Infant wide-field fundus photograph · 1240 by 1240 pixels
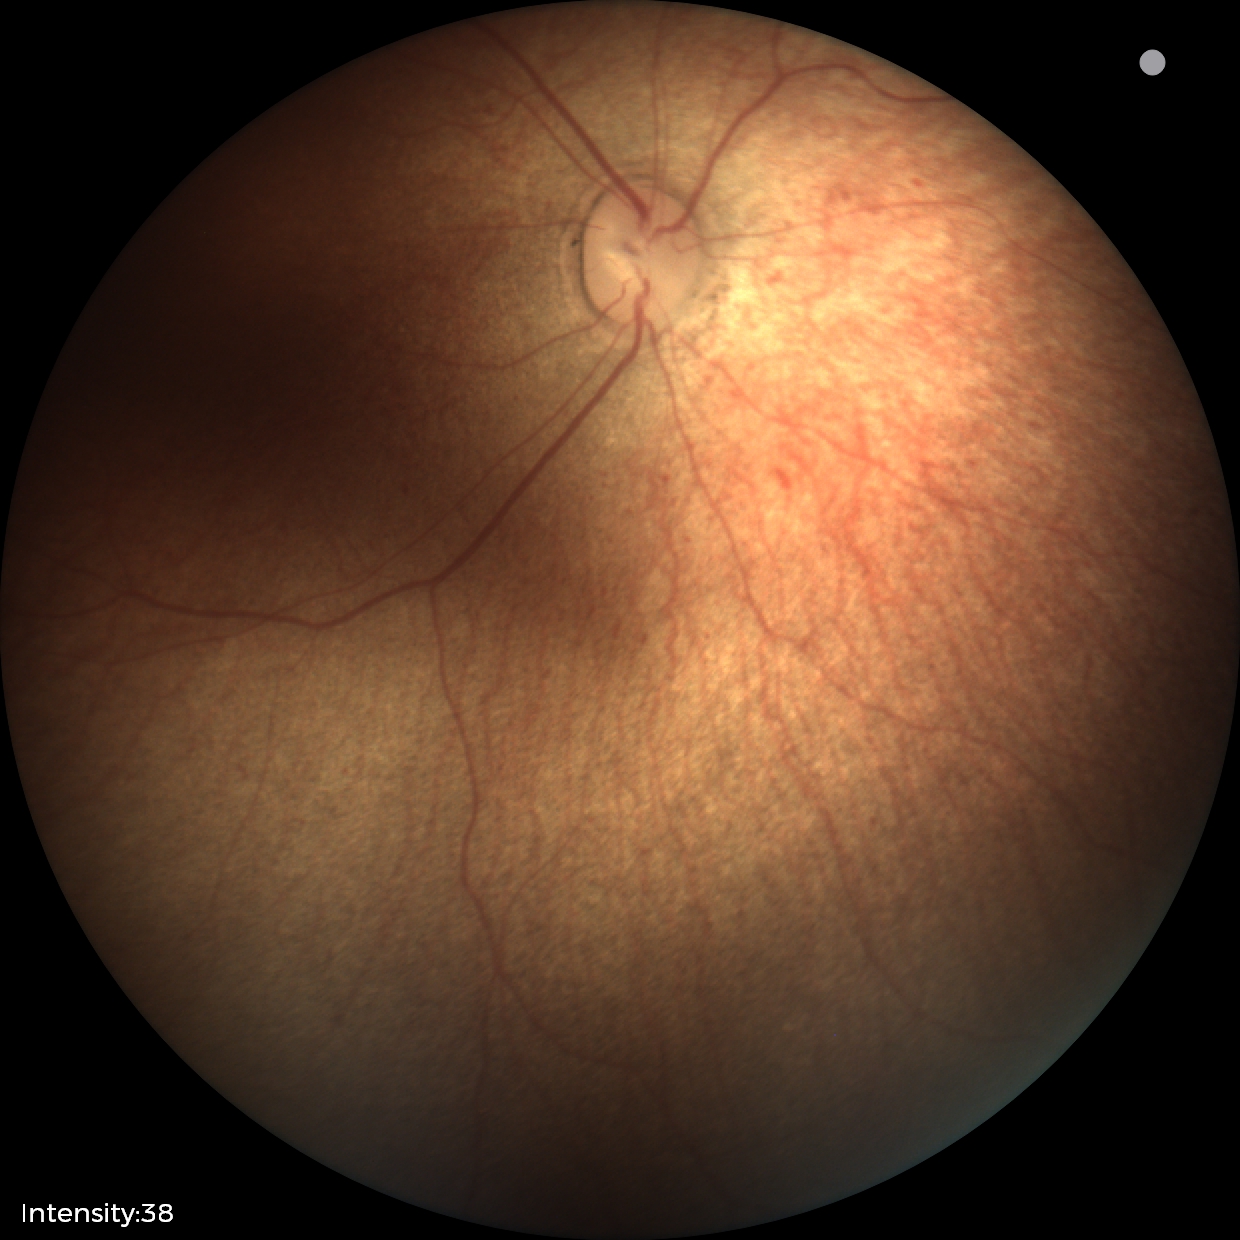
Examination with physiological retinal findings.